Infant wide-field retinal image — 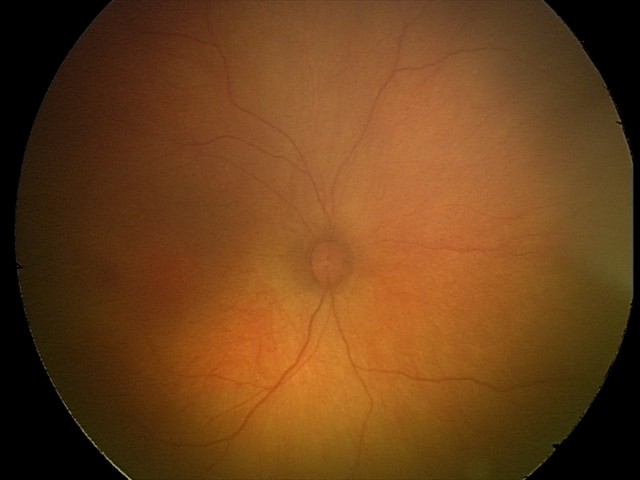
Screening diagnosis: no abnormalities